Nonmydriatic fundus photograph. 45 degree fundus photograph: 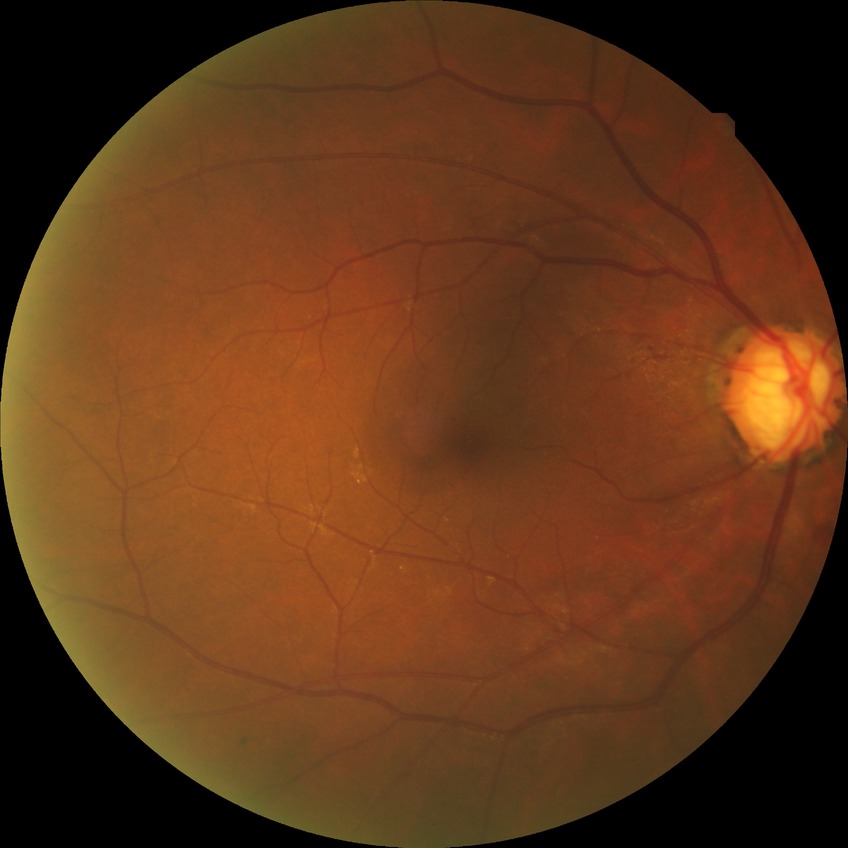
Retinopathy stage: no diabetic retinopathy.